Posterior pole view — 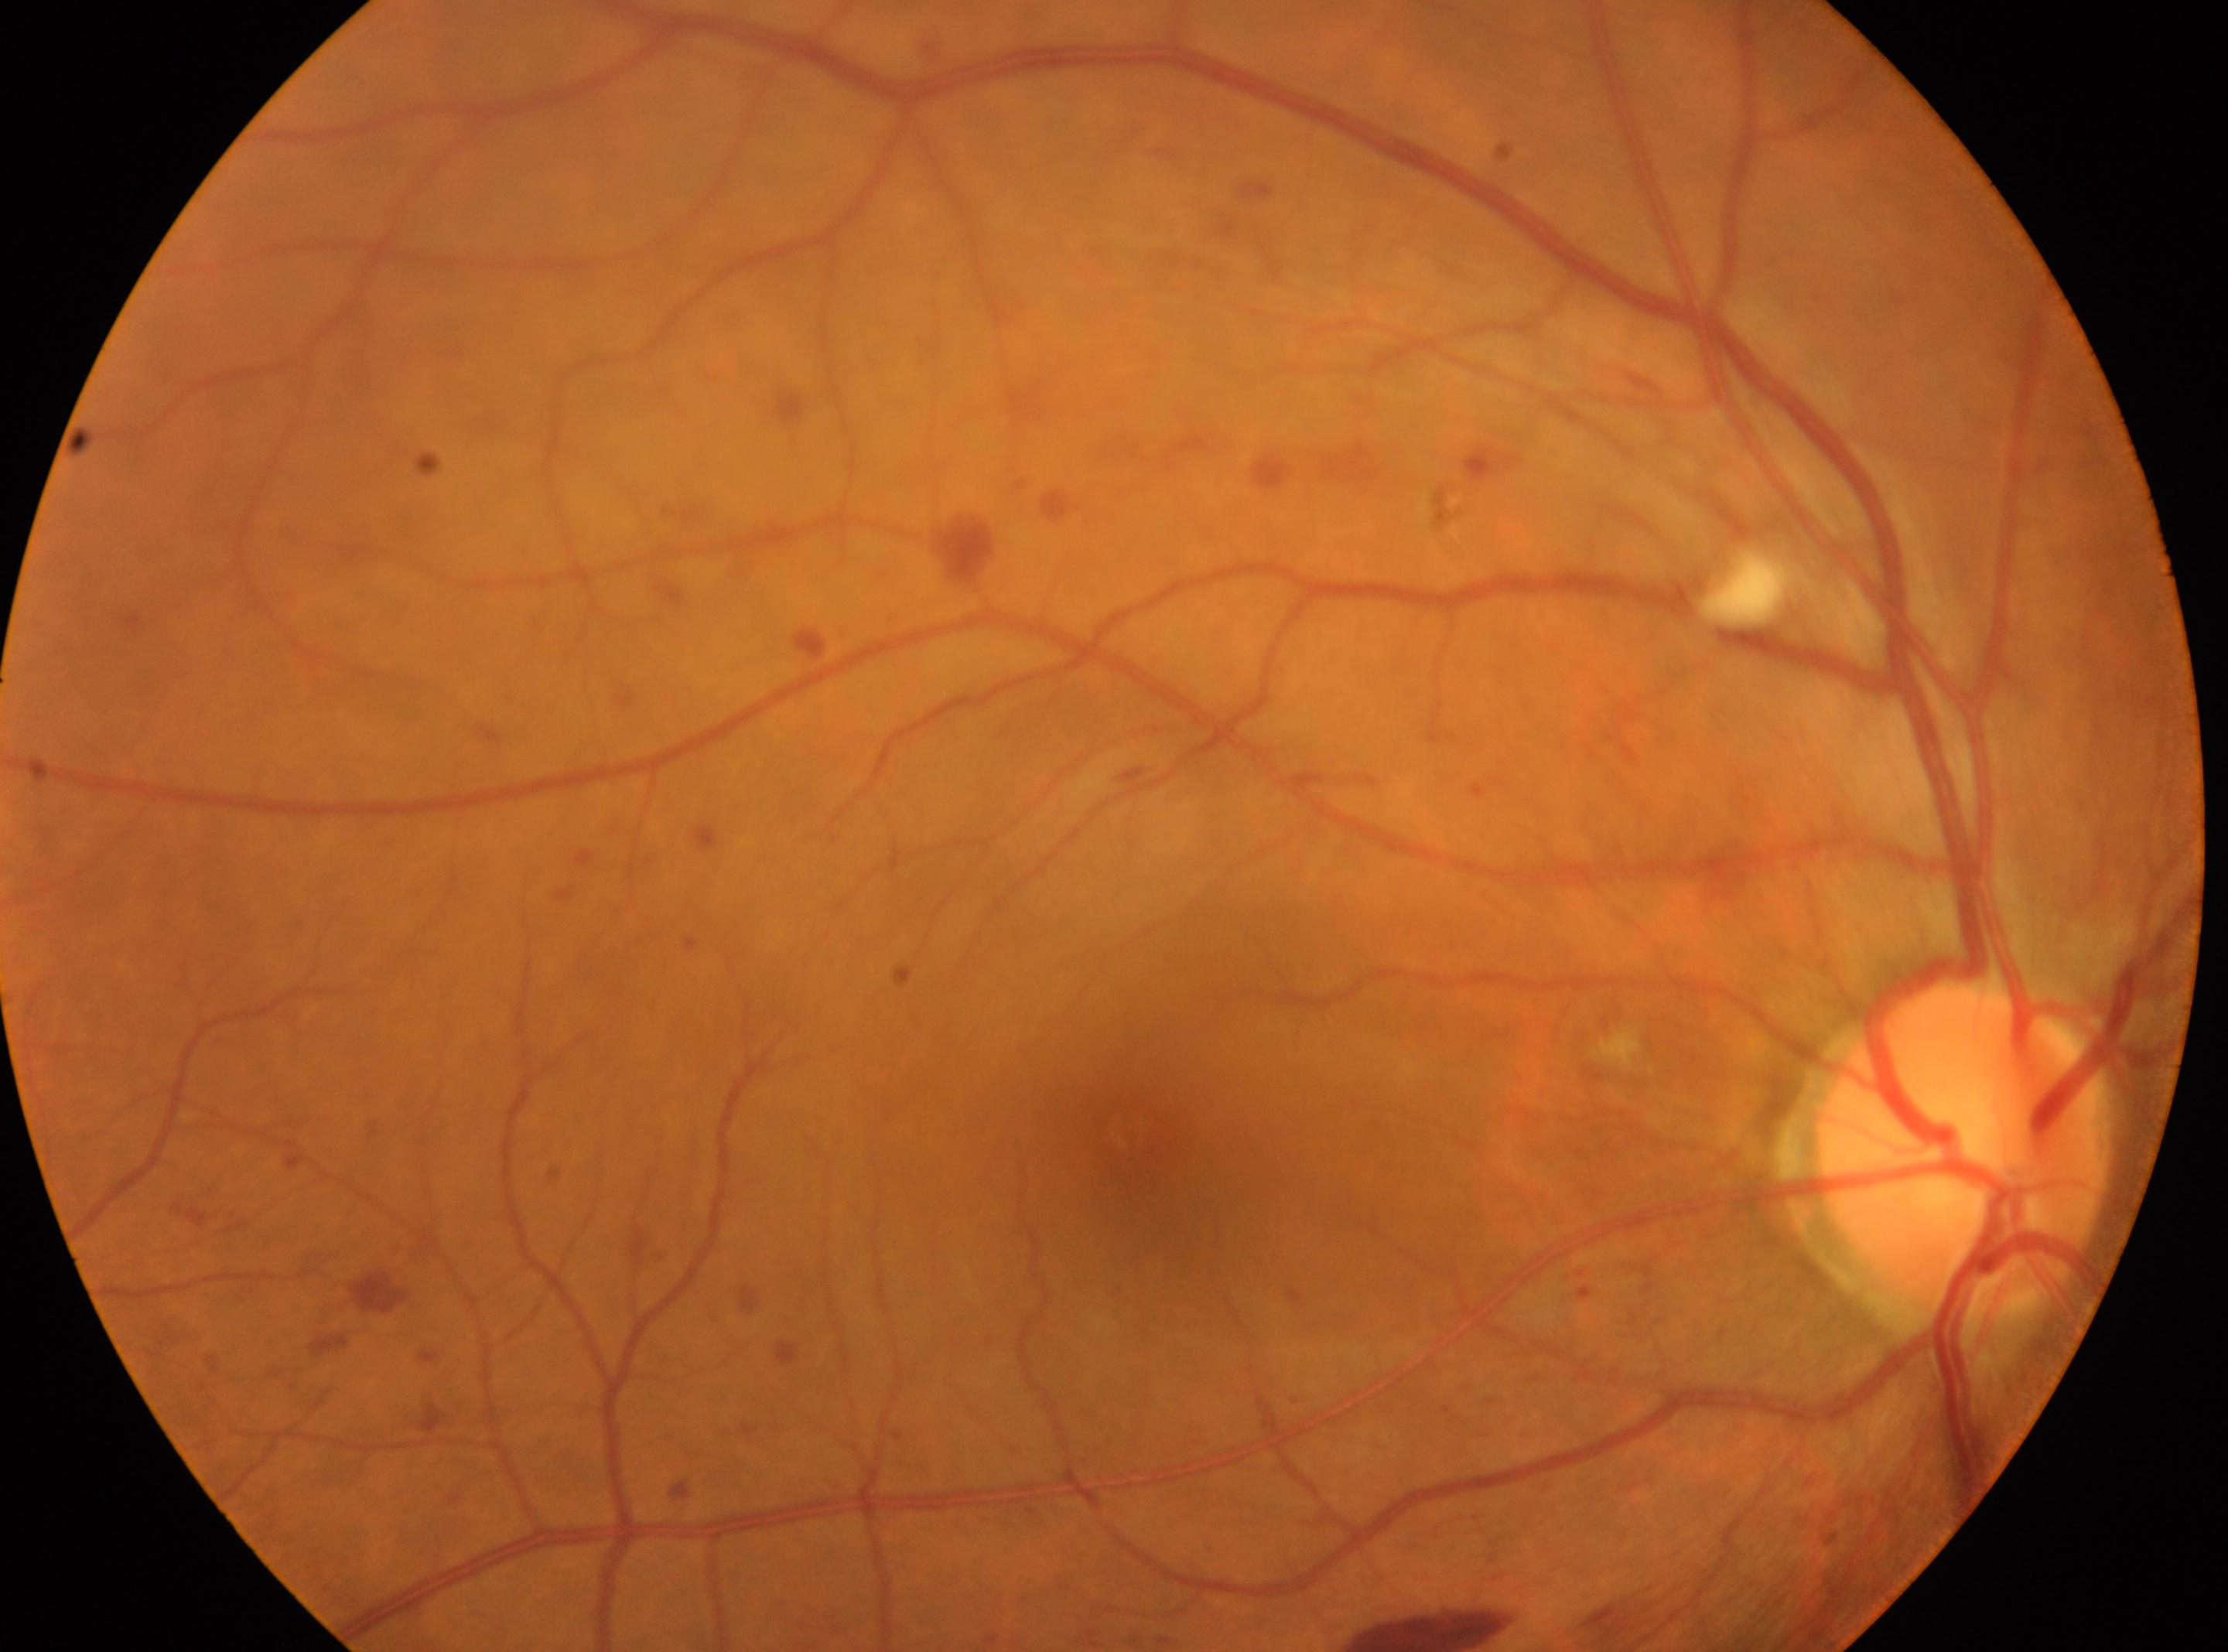

ONH: (1960, 1145). Fovea: (1129, 1138). Imaged eye: right eye. DR: 3/4.